Color fundus photograph. Without pupil dilation. Davis DR grading. FOV: 45 degrees
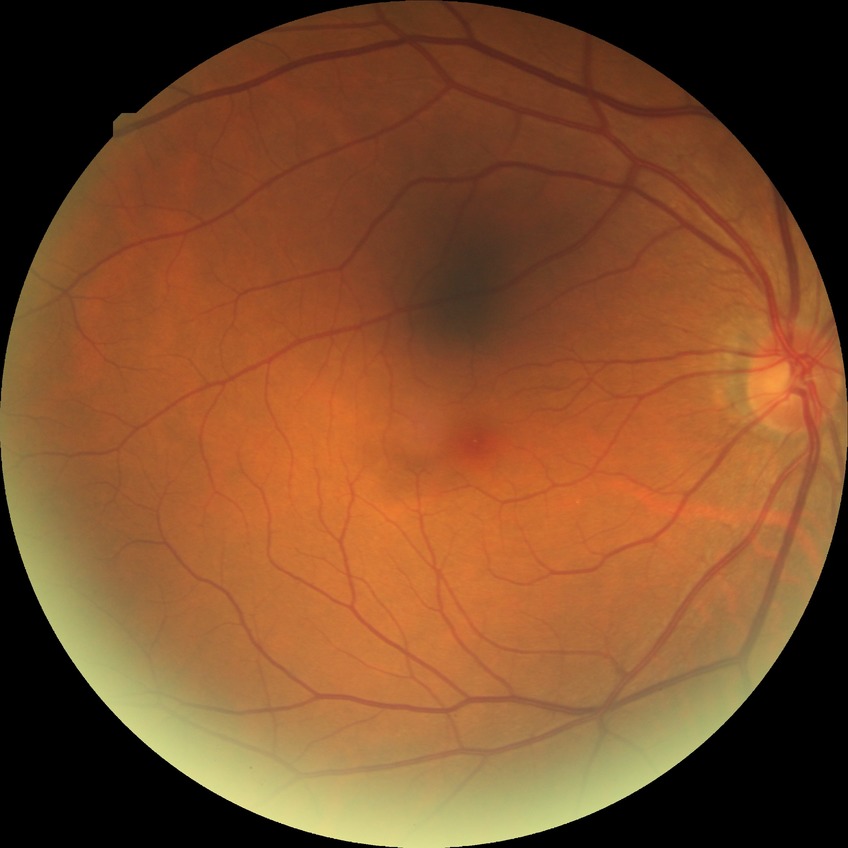
- retinopathy stage — no diabetic retinopathy